Modified Davis classification; 848x848px; FOV: 45 degrees: 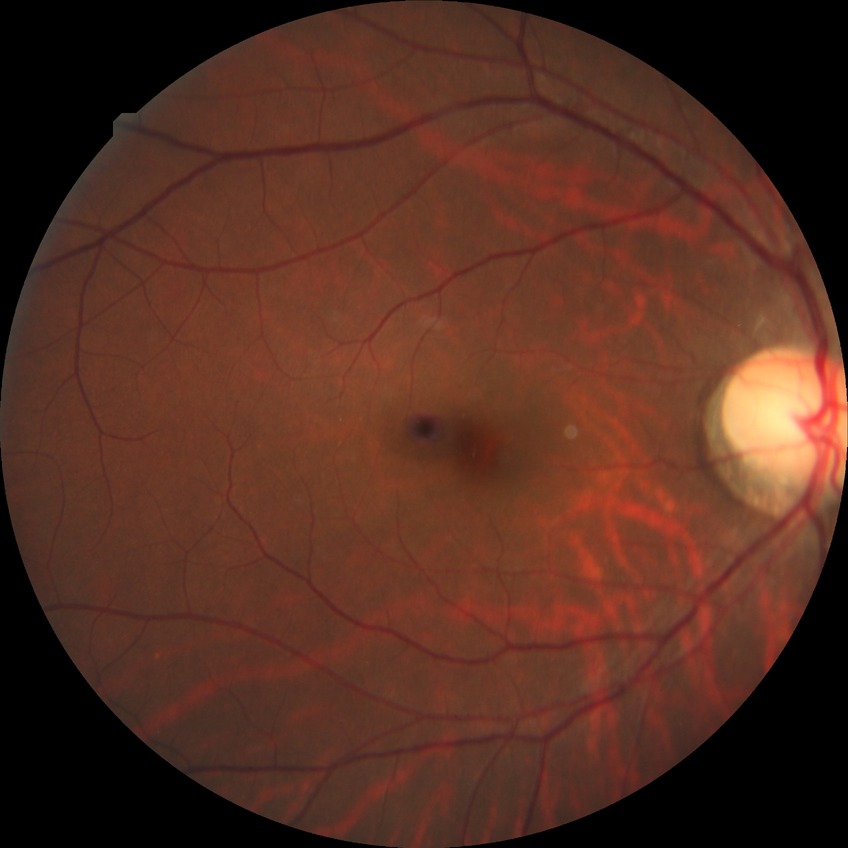

  davis_grade: no diabetic retinopathy (NDR)